45 degree fundus photograph: 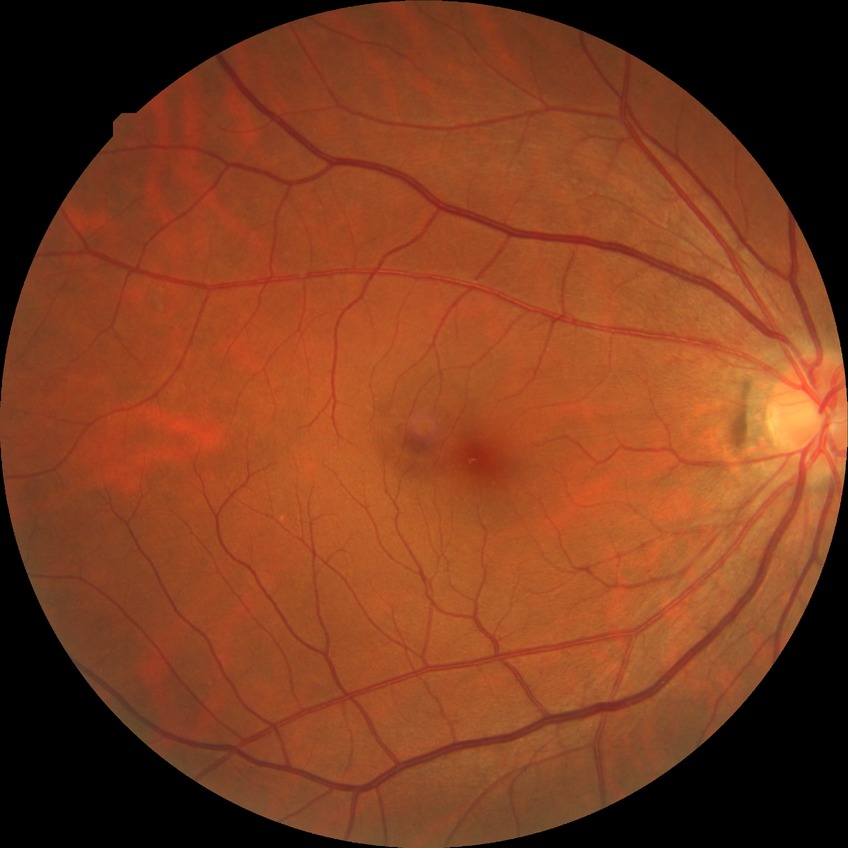
diabetic retinopathy (DR): NDR (no diabetic retinopathy).